Acquired with a Bosch handheld camera — 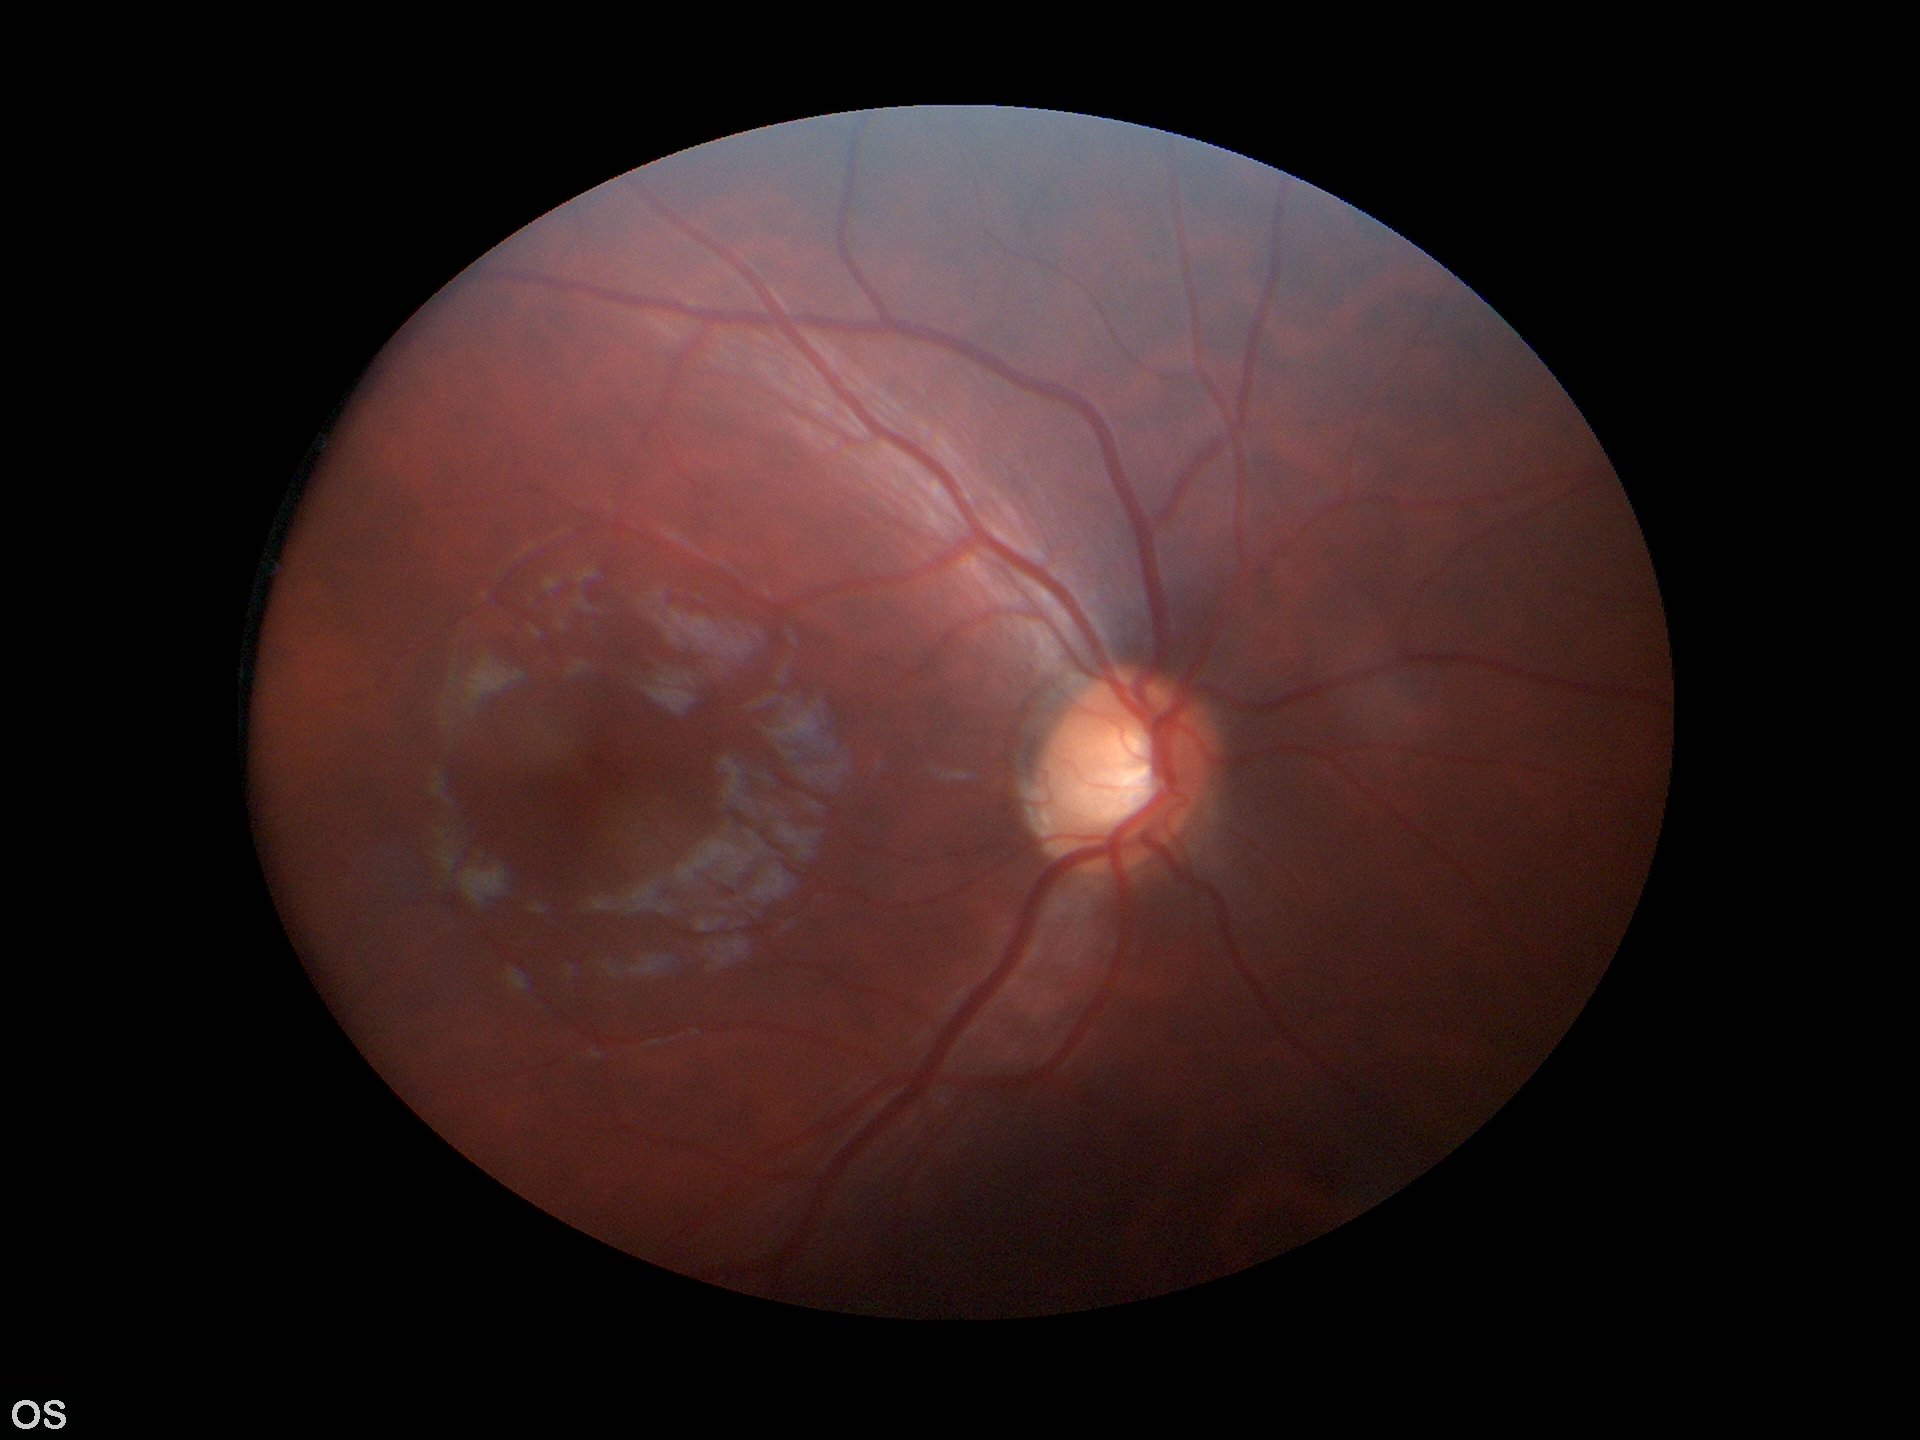

Glaucoma impression: no suspicious findings; vertical cup-to-disc ratio (VCDR): 0.59; area CDR (ACDR): 0.34; horizontal CDR (HCDR): 0.57